Graded on the modified Davis scale.
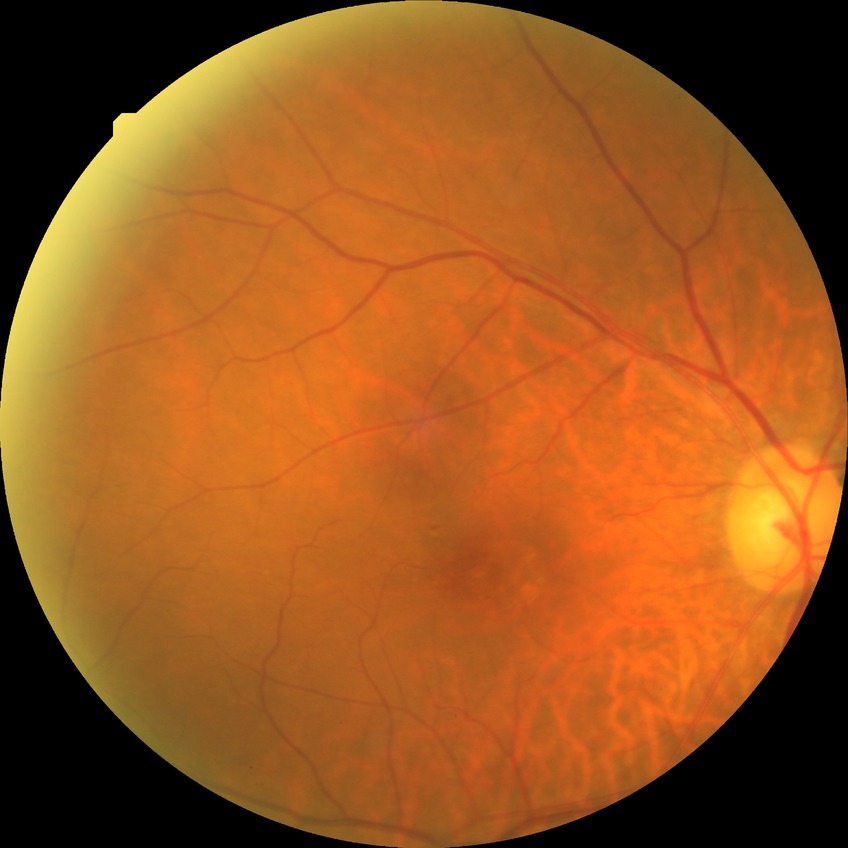

modified Davis grading: simple diabetic retinopathy.